640 by 480 pixels. Pediatric retinal photograph (wide-field).
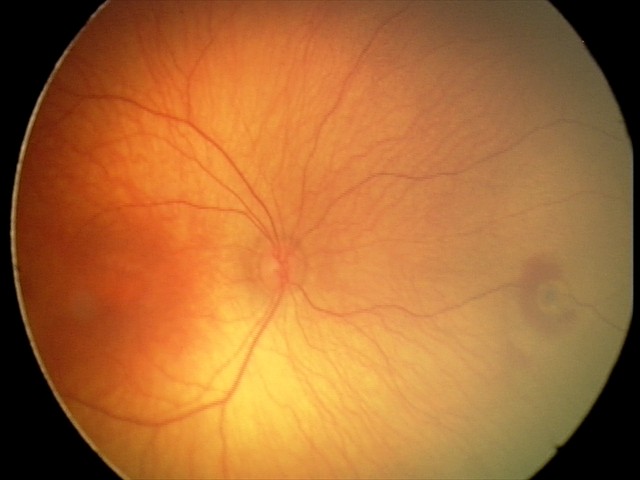
Impression = retinal hemorrhages